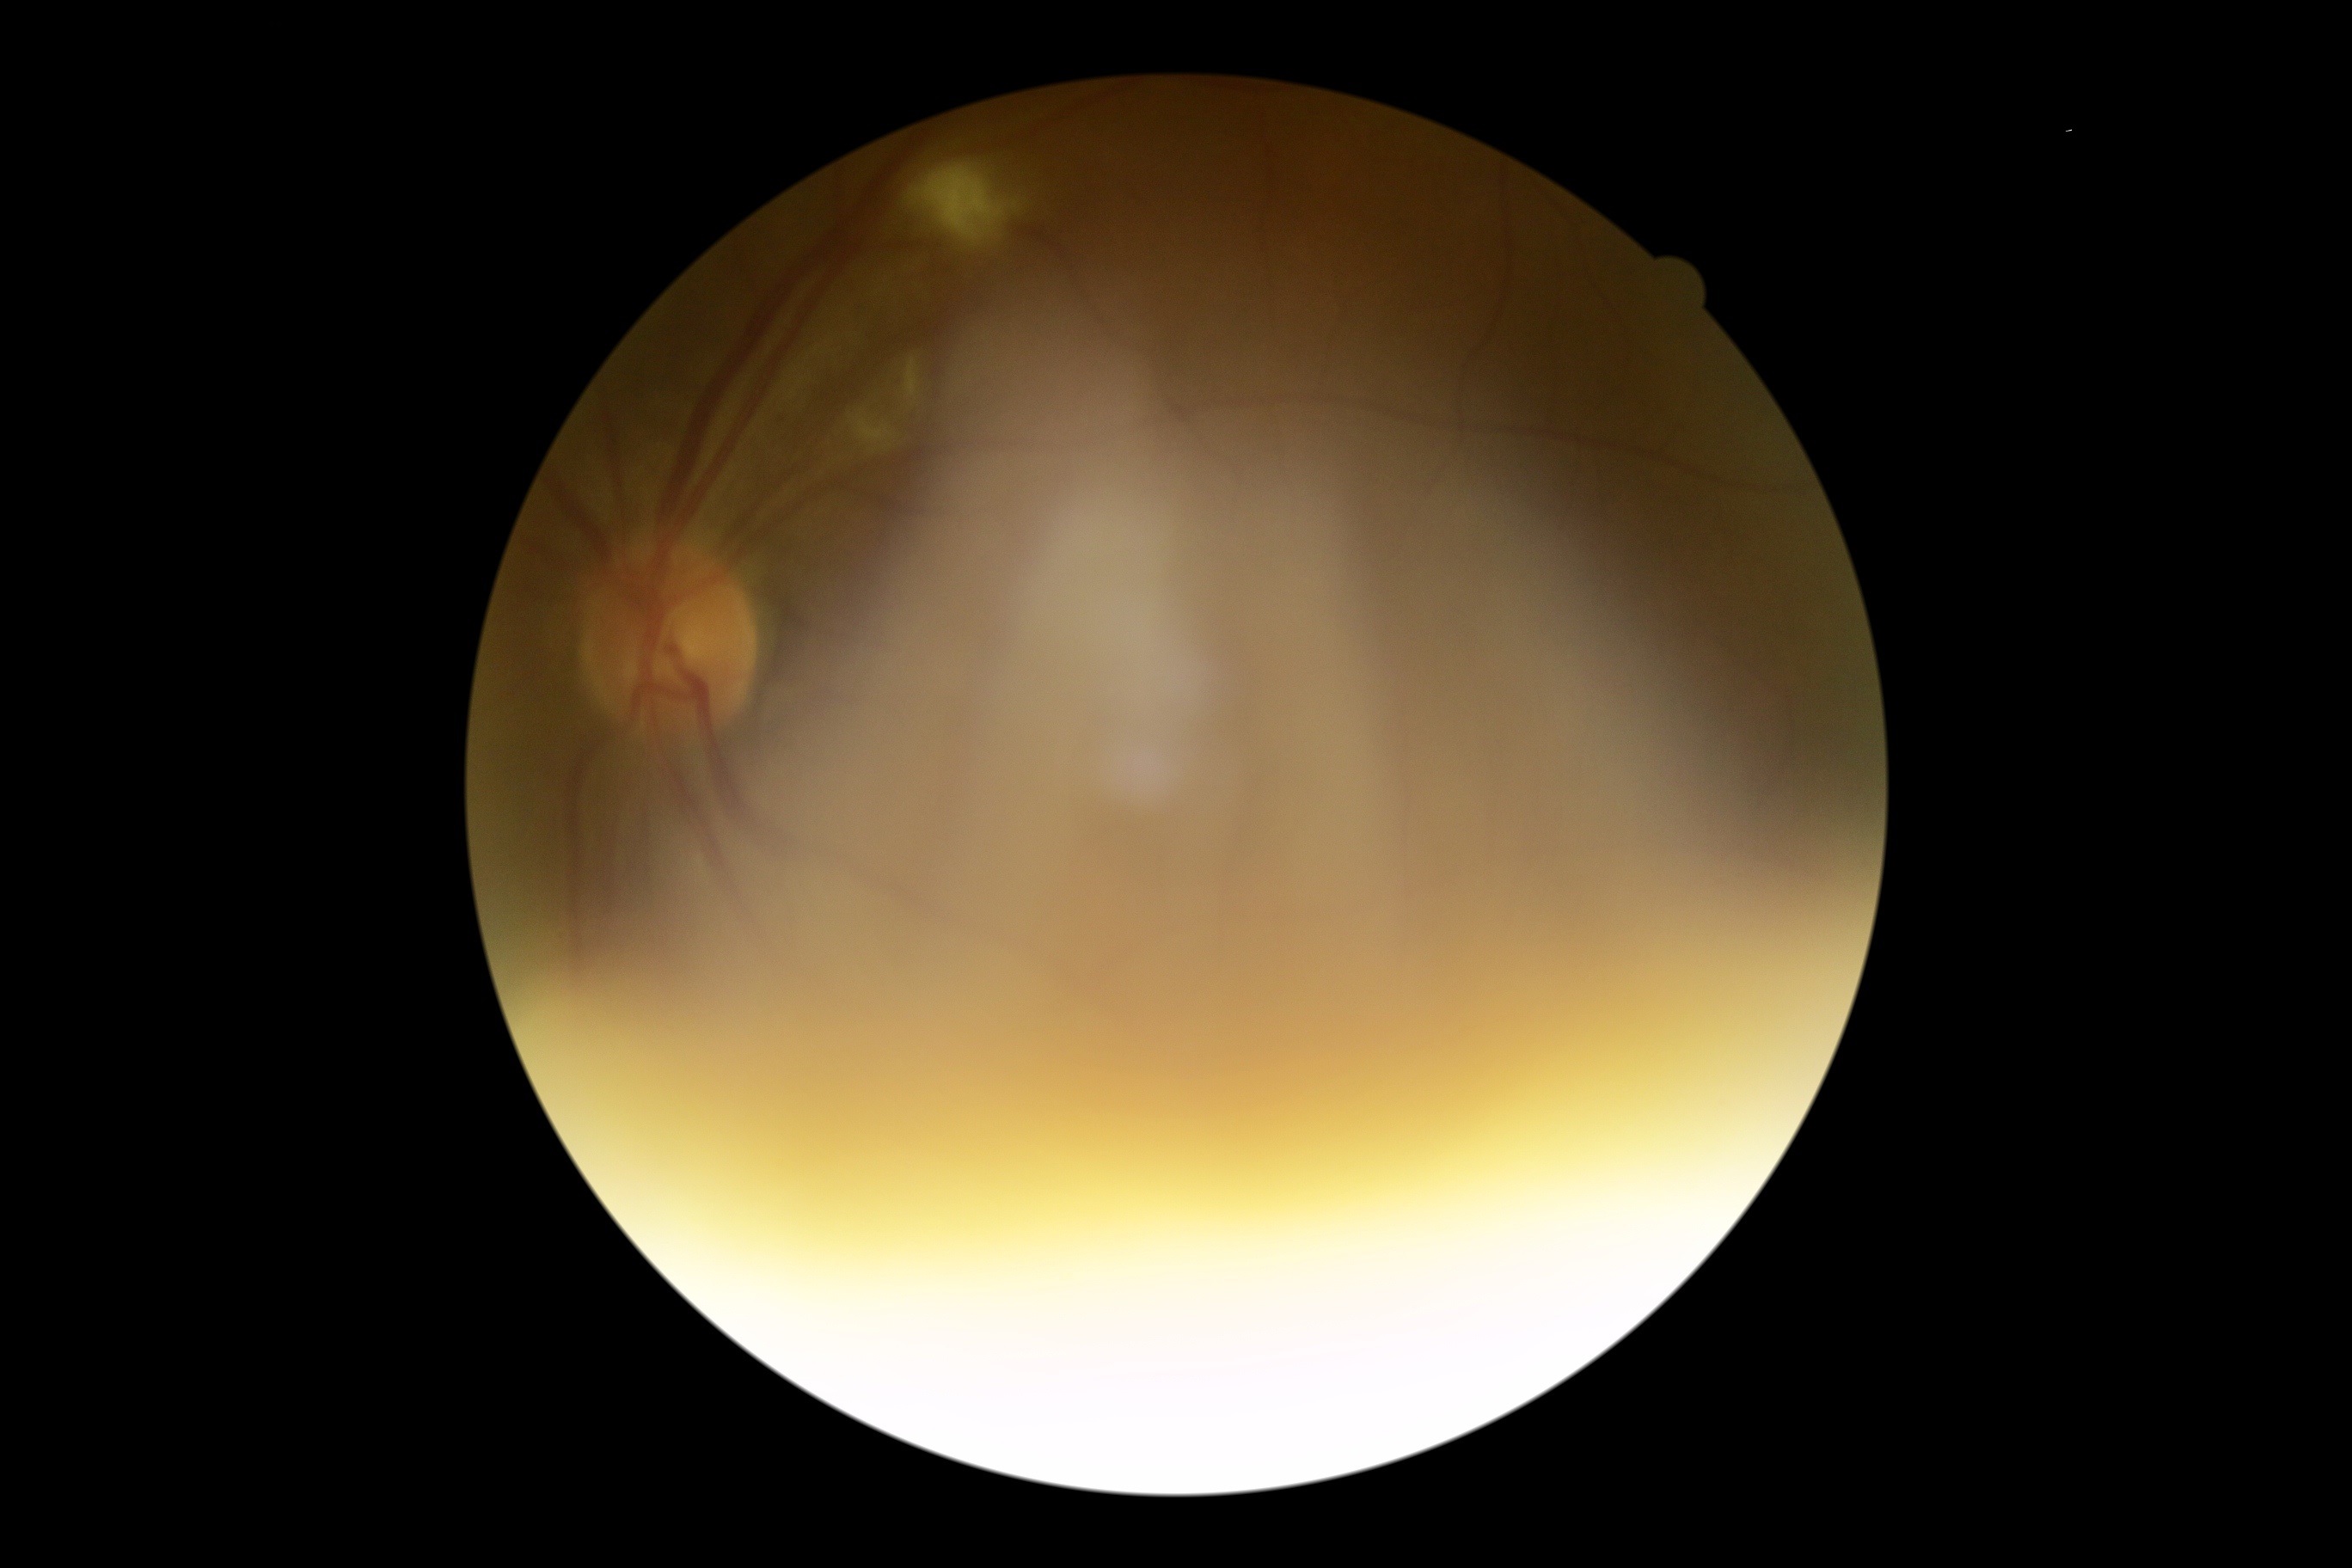 Diabetic retinopathy (DR) is grade 2 (moderate NPDR) — more than just microaneurysms but less than severe NPDR.